FOV 35° before cropping. Mydriatic. Fundus image cropped to the optic disc: 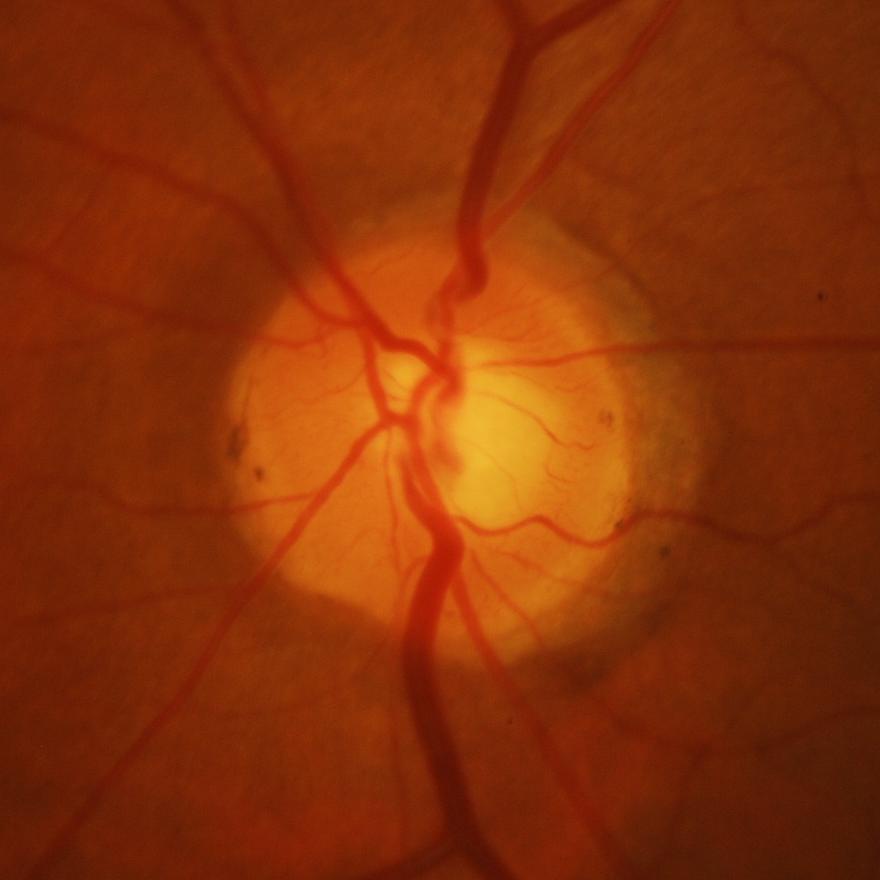 Evidence of glaucoma.